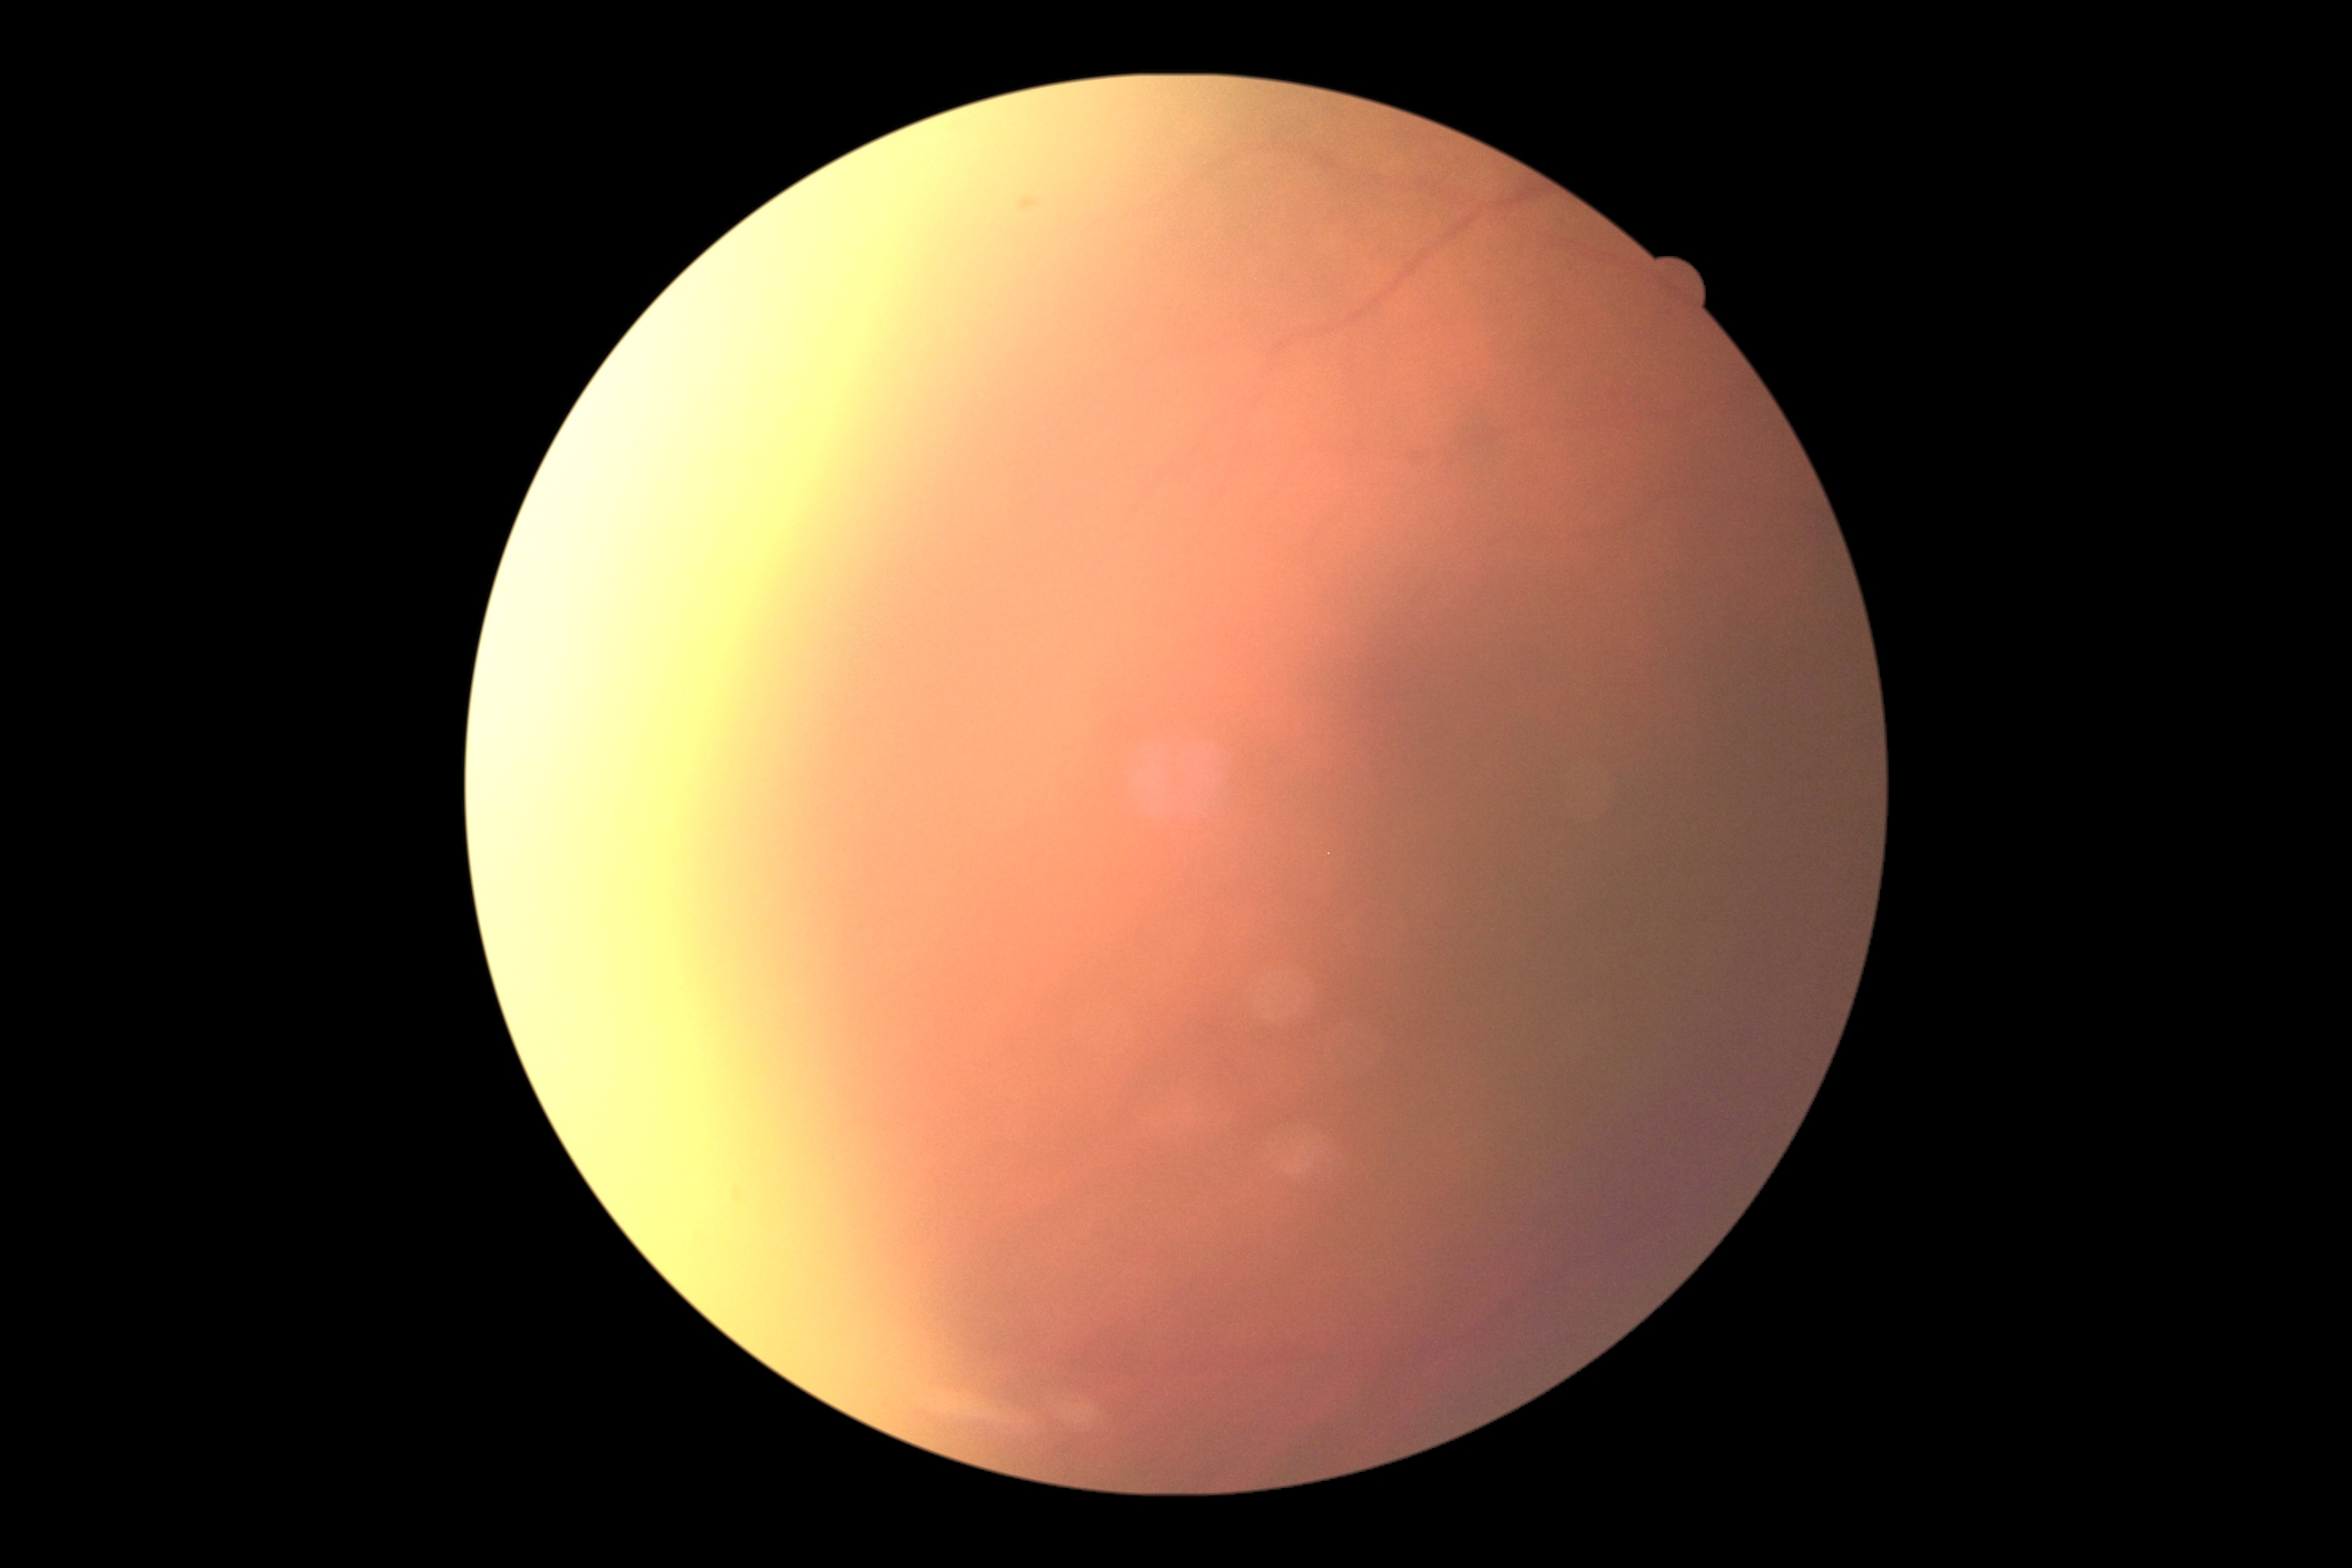
Image quality is insufficient for diabetic retinopathy assessment.
DR grade: ungradable due to poor image quality.